1659x2212px. Retinal fundus photograph: 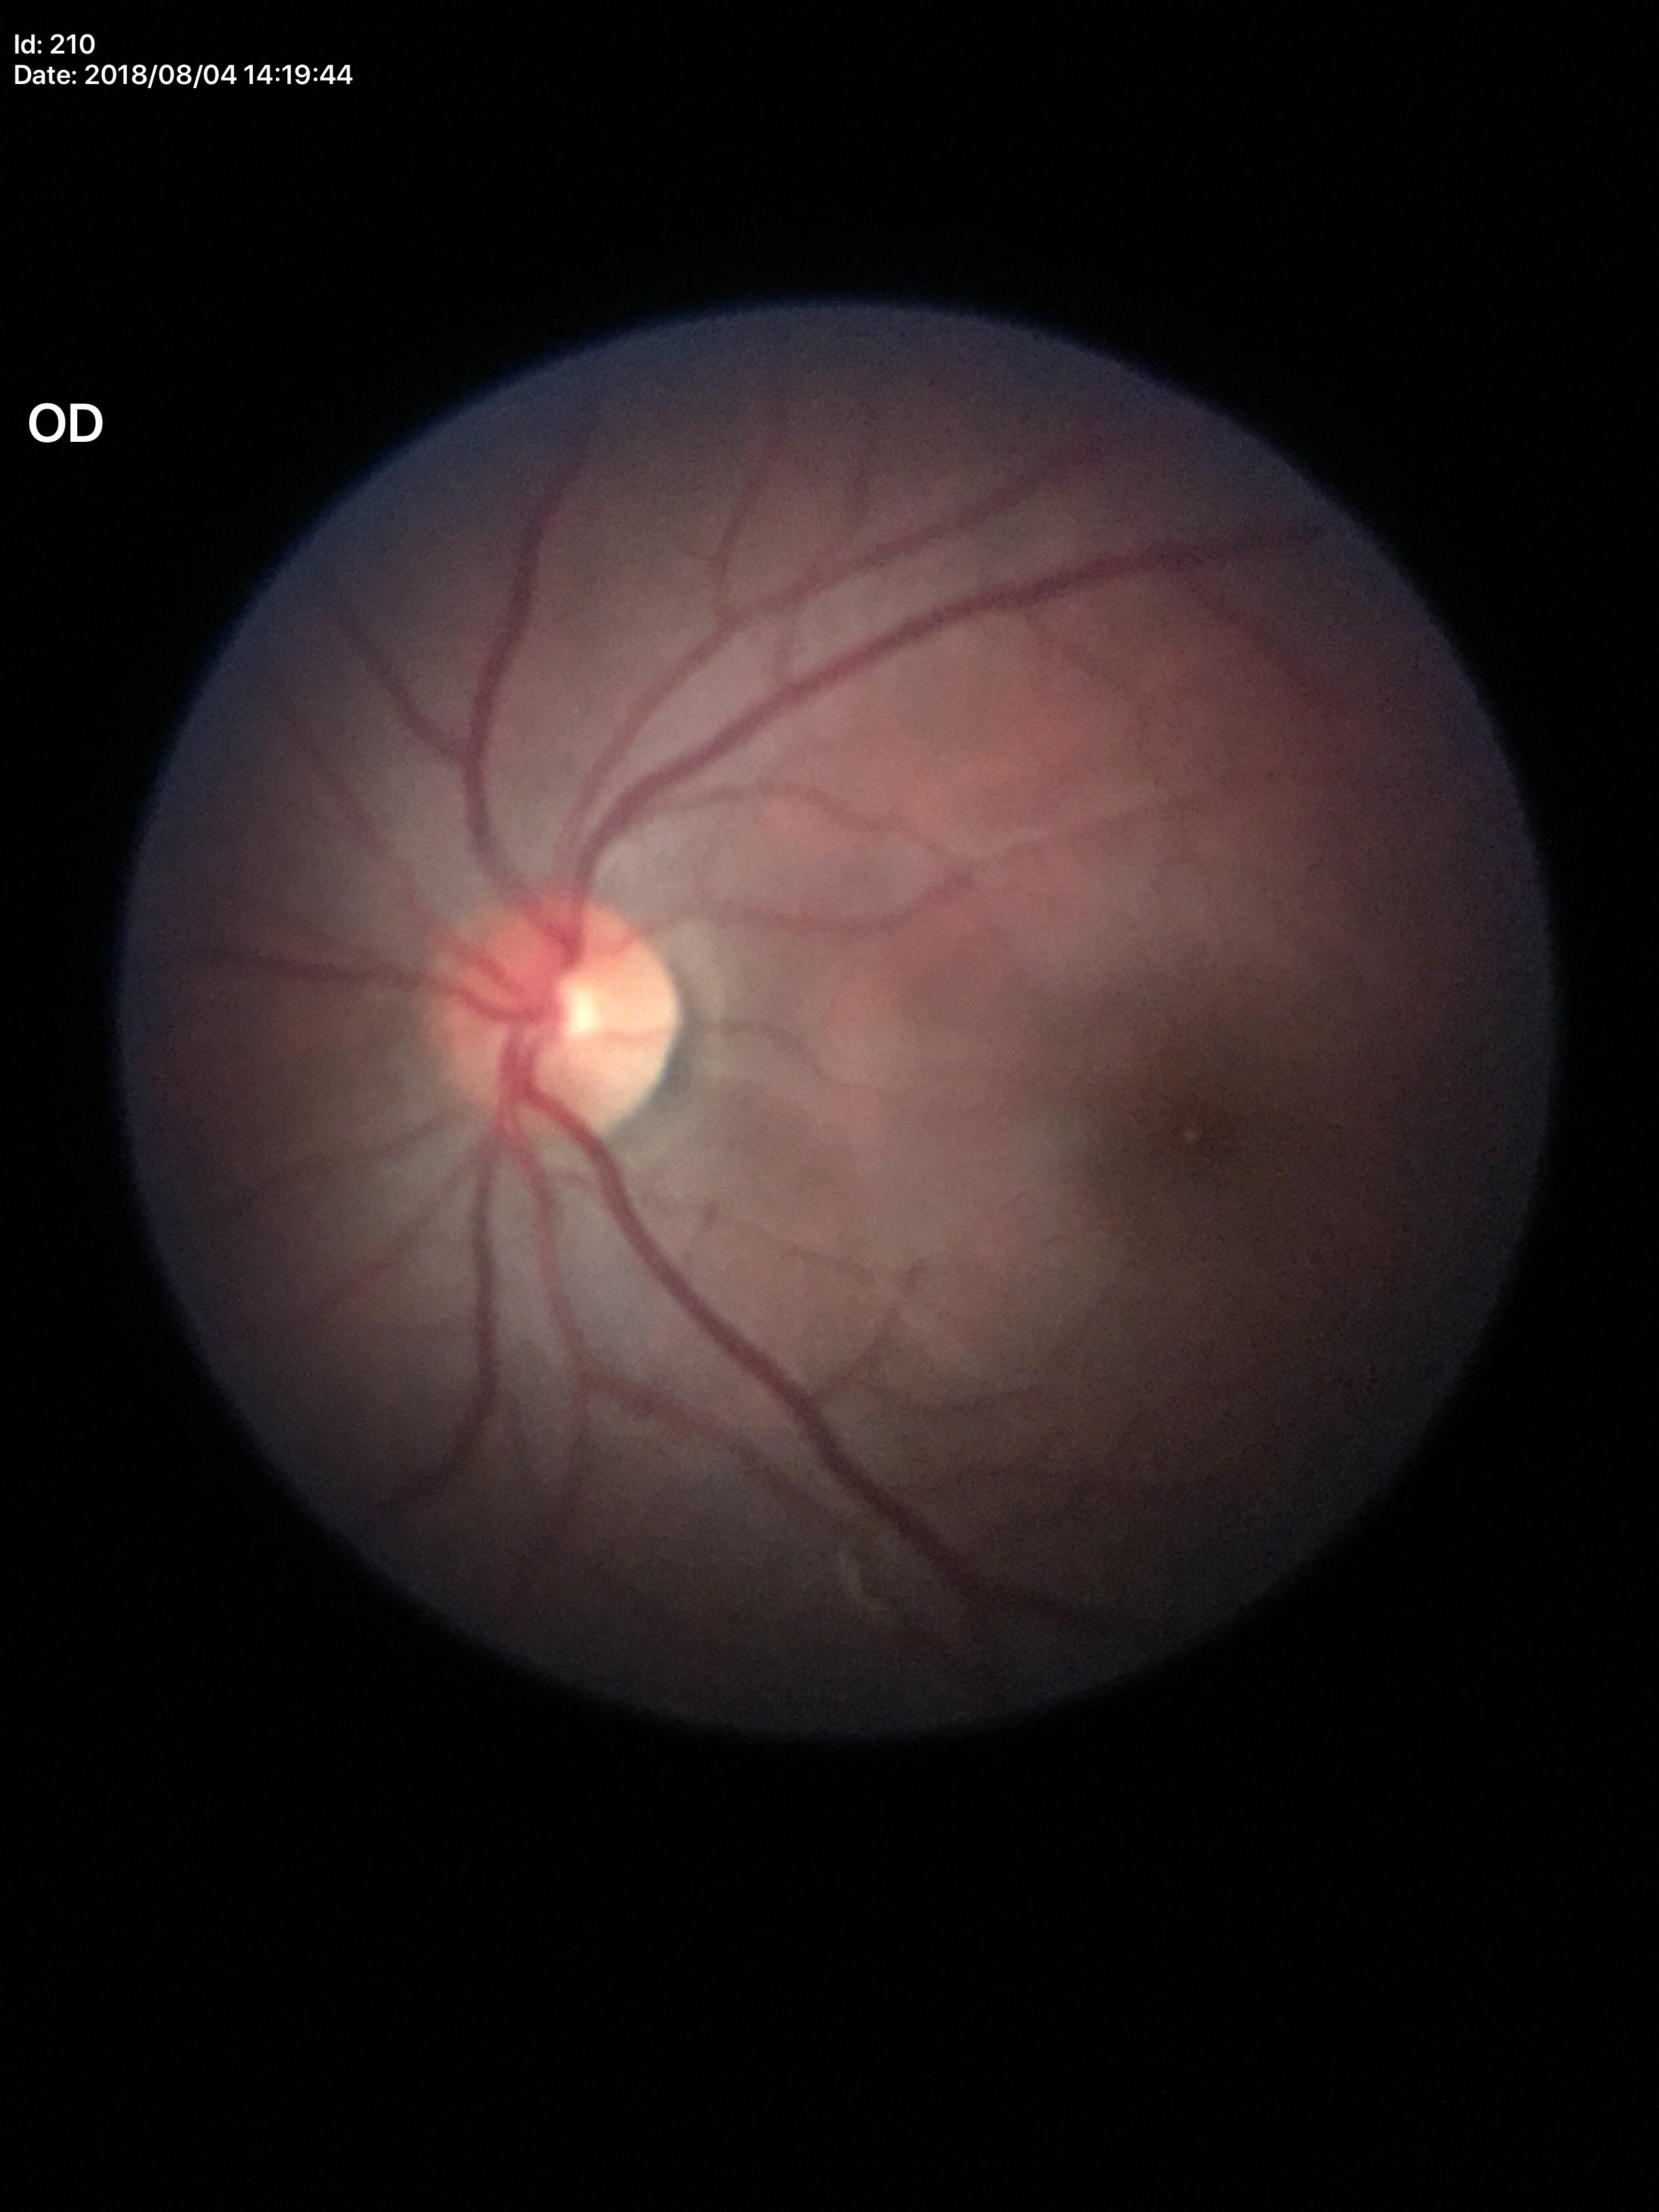 Q: What is the glaucoma assessment?
A: negative (unanimous normal call)
Q: Vertical CDR?
A: 0.42